Without pupil dilation. Retinal fundus photograph — 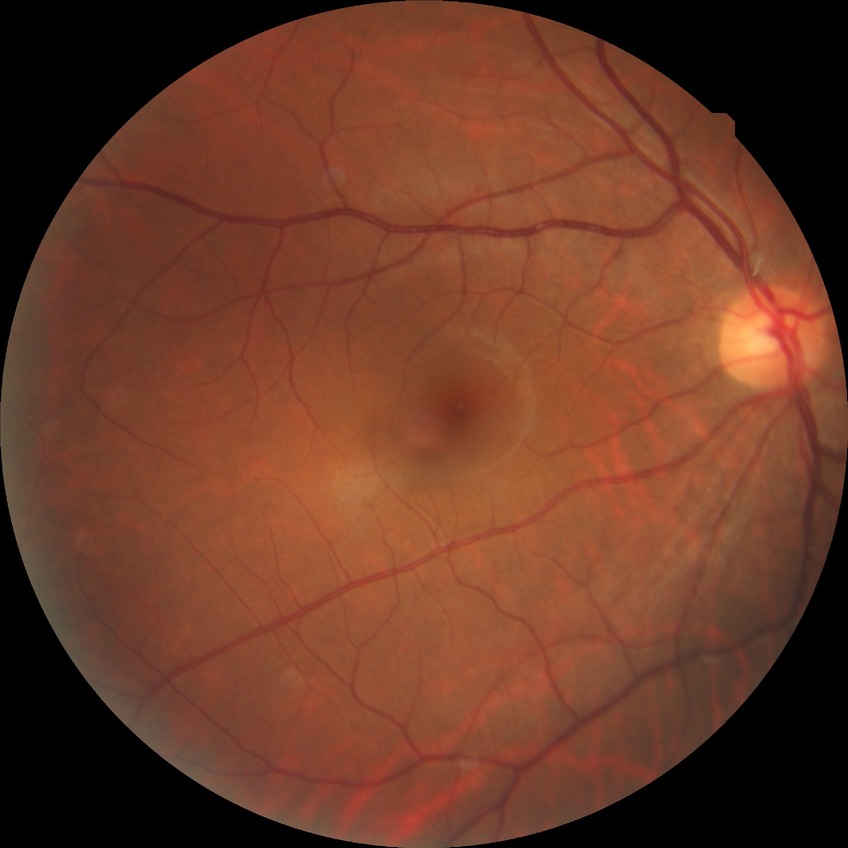
DR stage: NDR.